Retinal fundus photograph · 2212 x 1659 pixels — 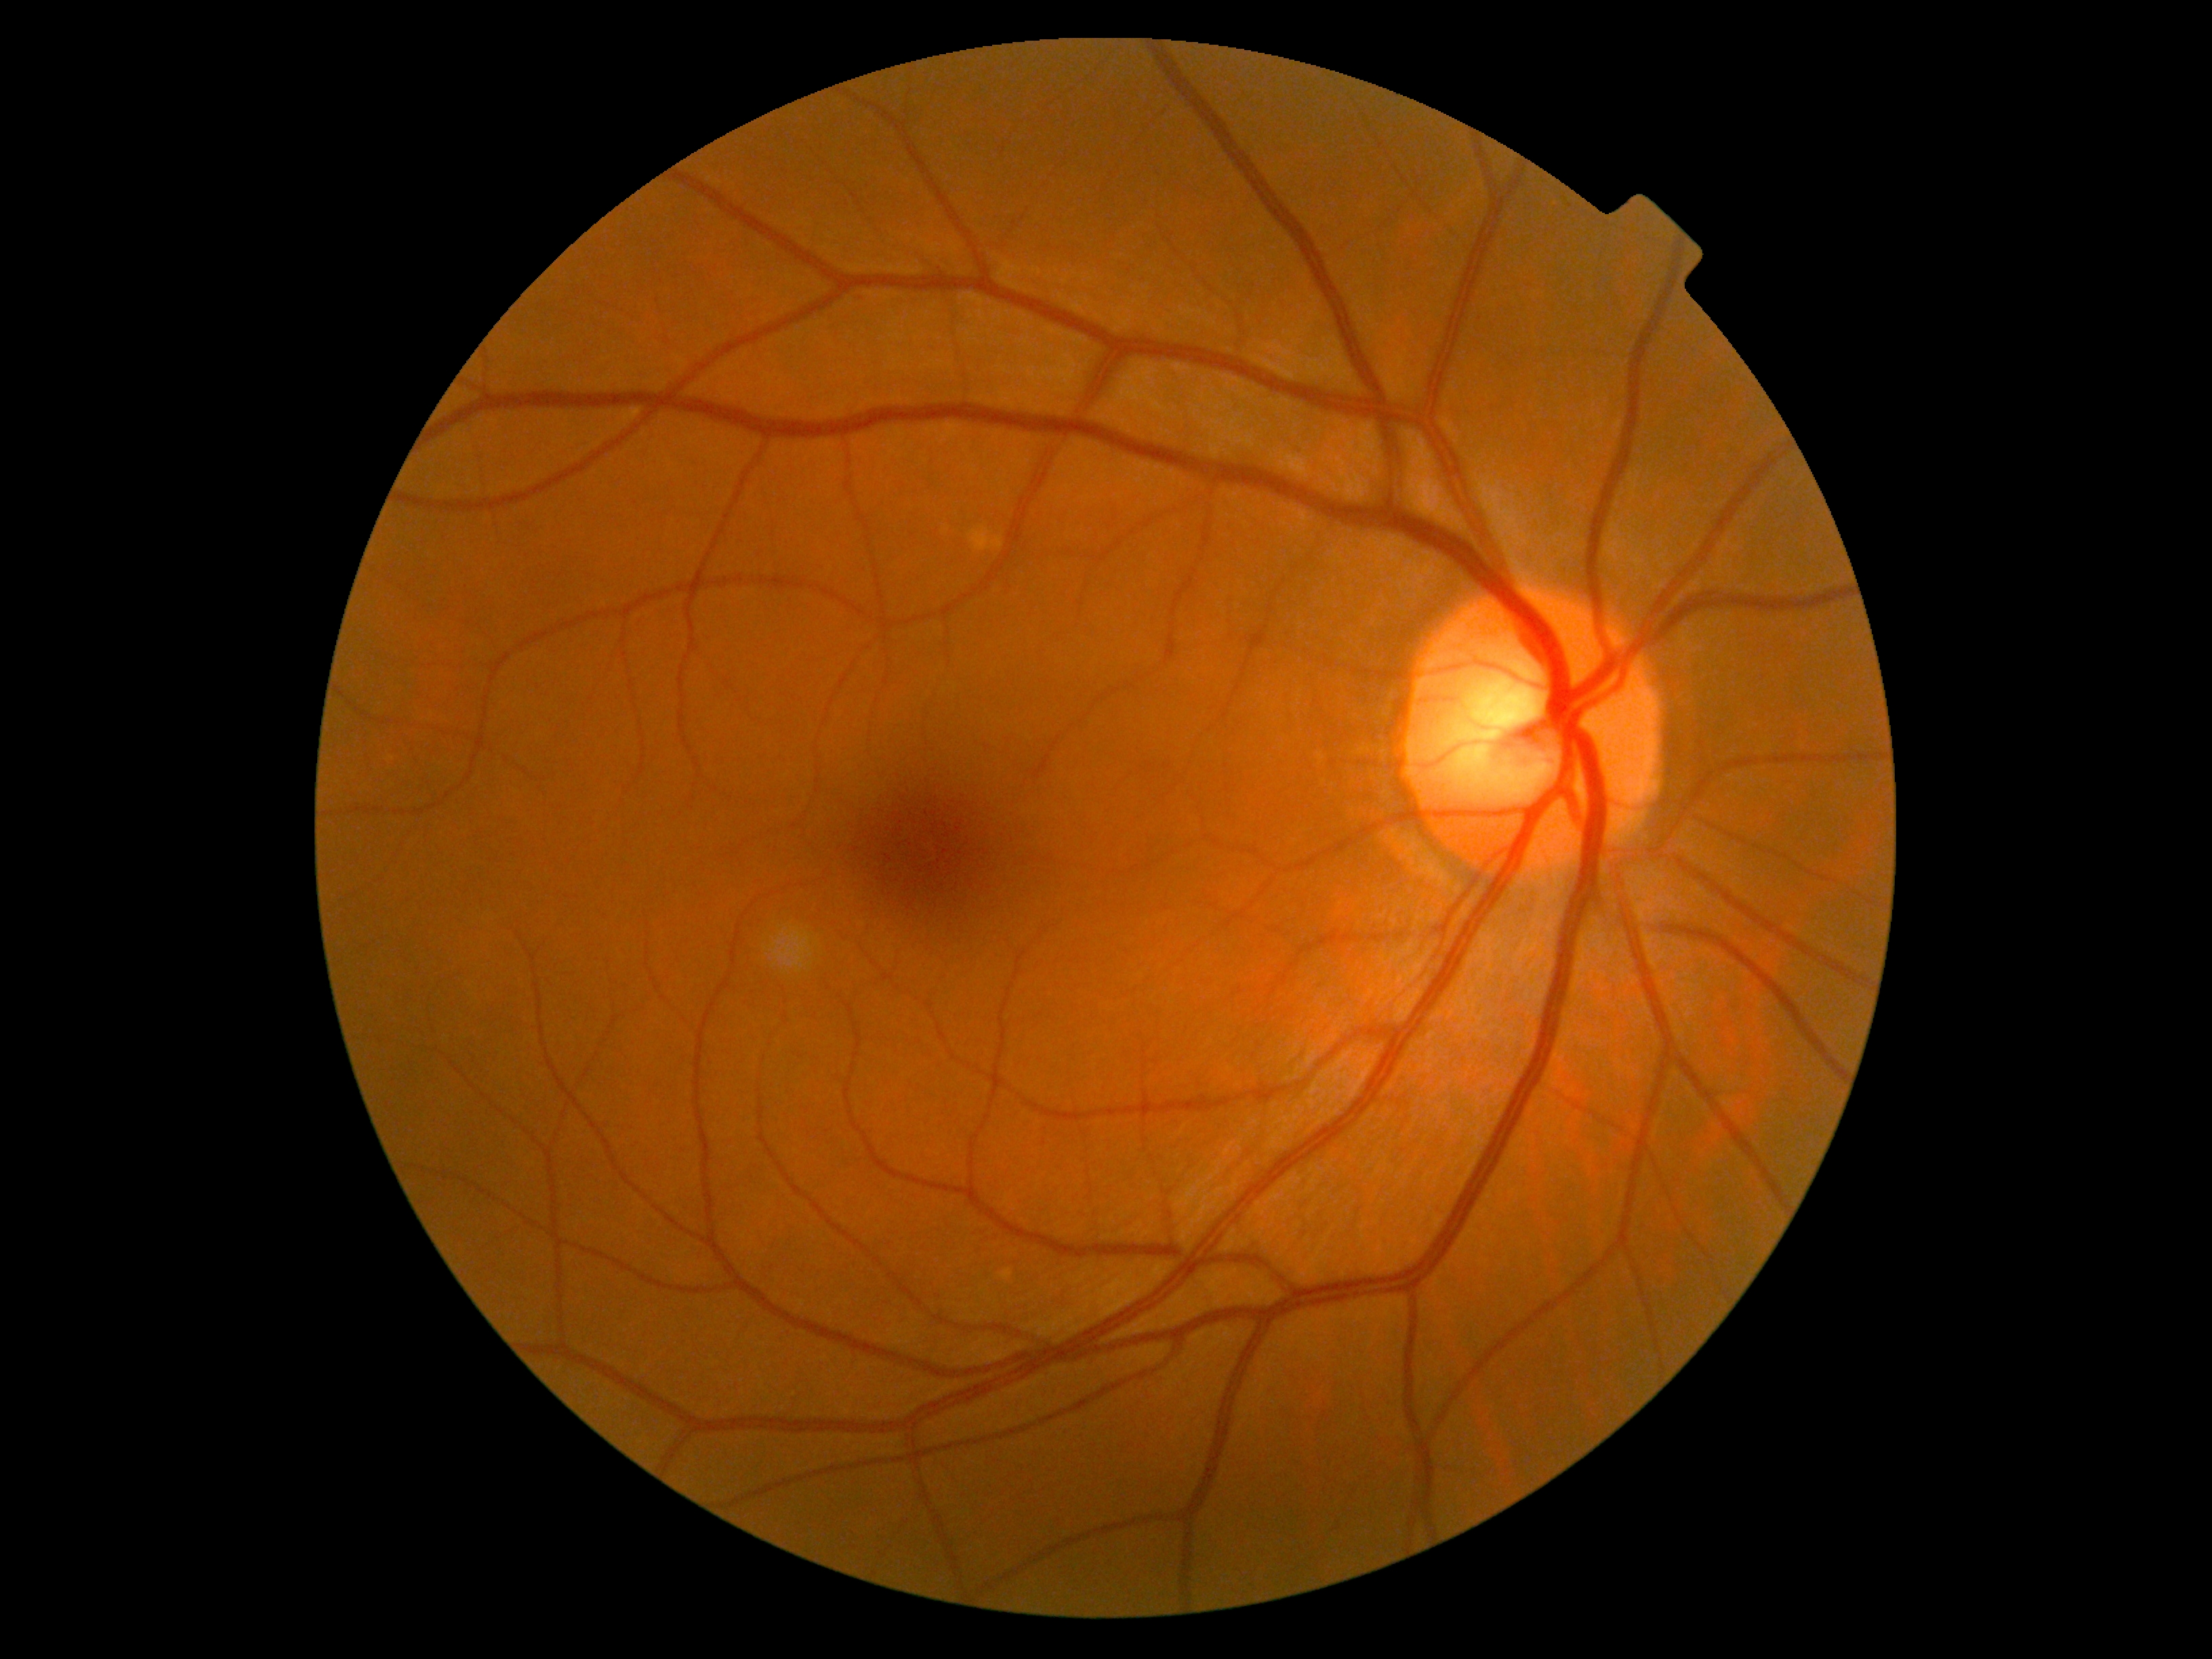
No DR findings.
Diabetic retinopathy severity: 0.